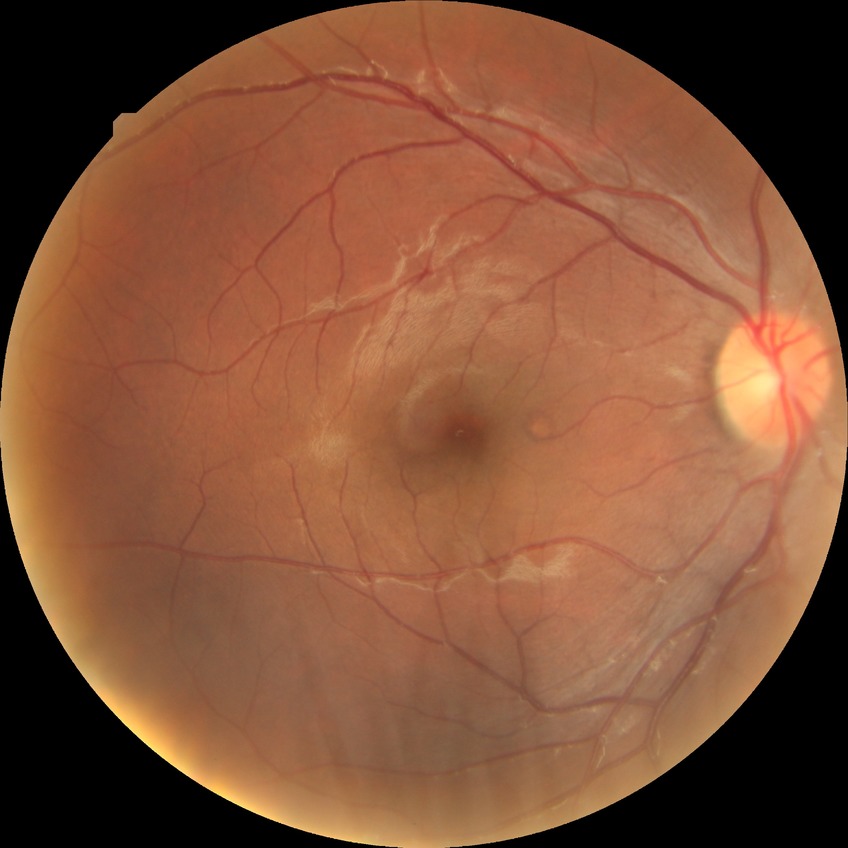 Diabetic retinopathy (DR) is NDR (no diabetic retinopathy).